Wide-field contact fundus photograph of an infant · 1440 x 1080 pixels:
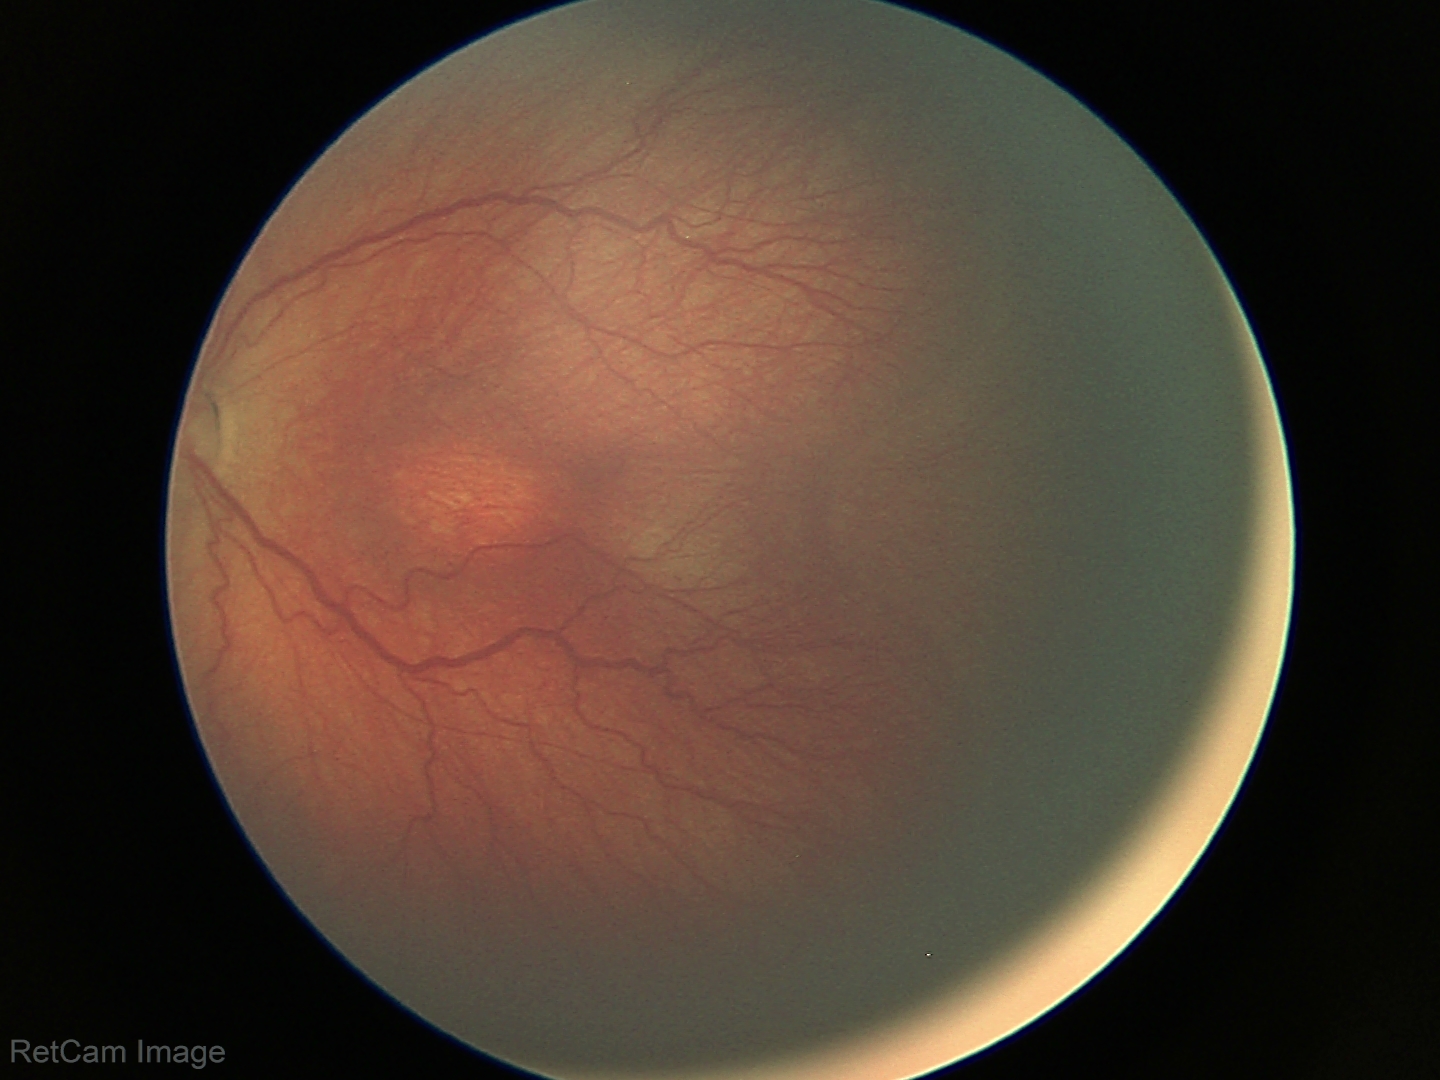
Without plus disease.
Screening series with retinopathy of prematurity (ROP) stage 3 — ridge with extraretinal fibrovascular proliferation.